Image size 2212x1659.
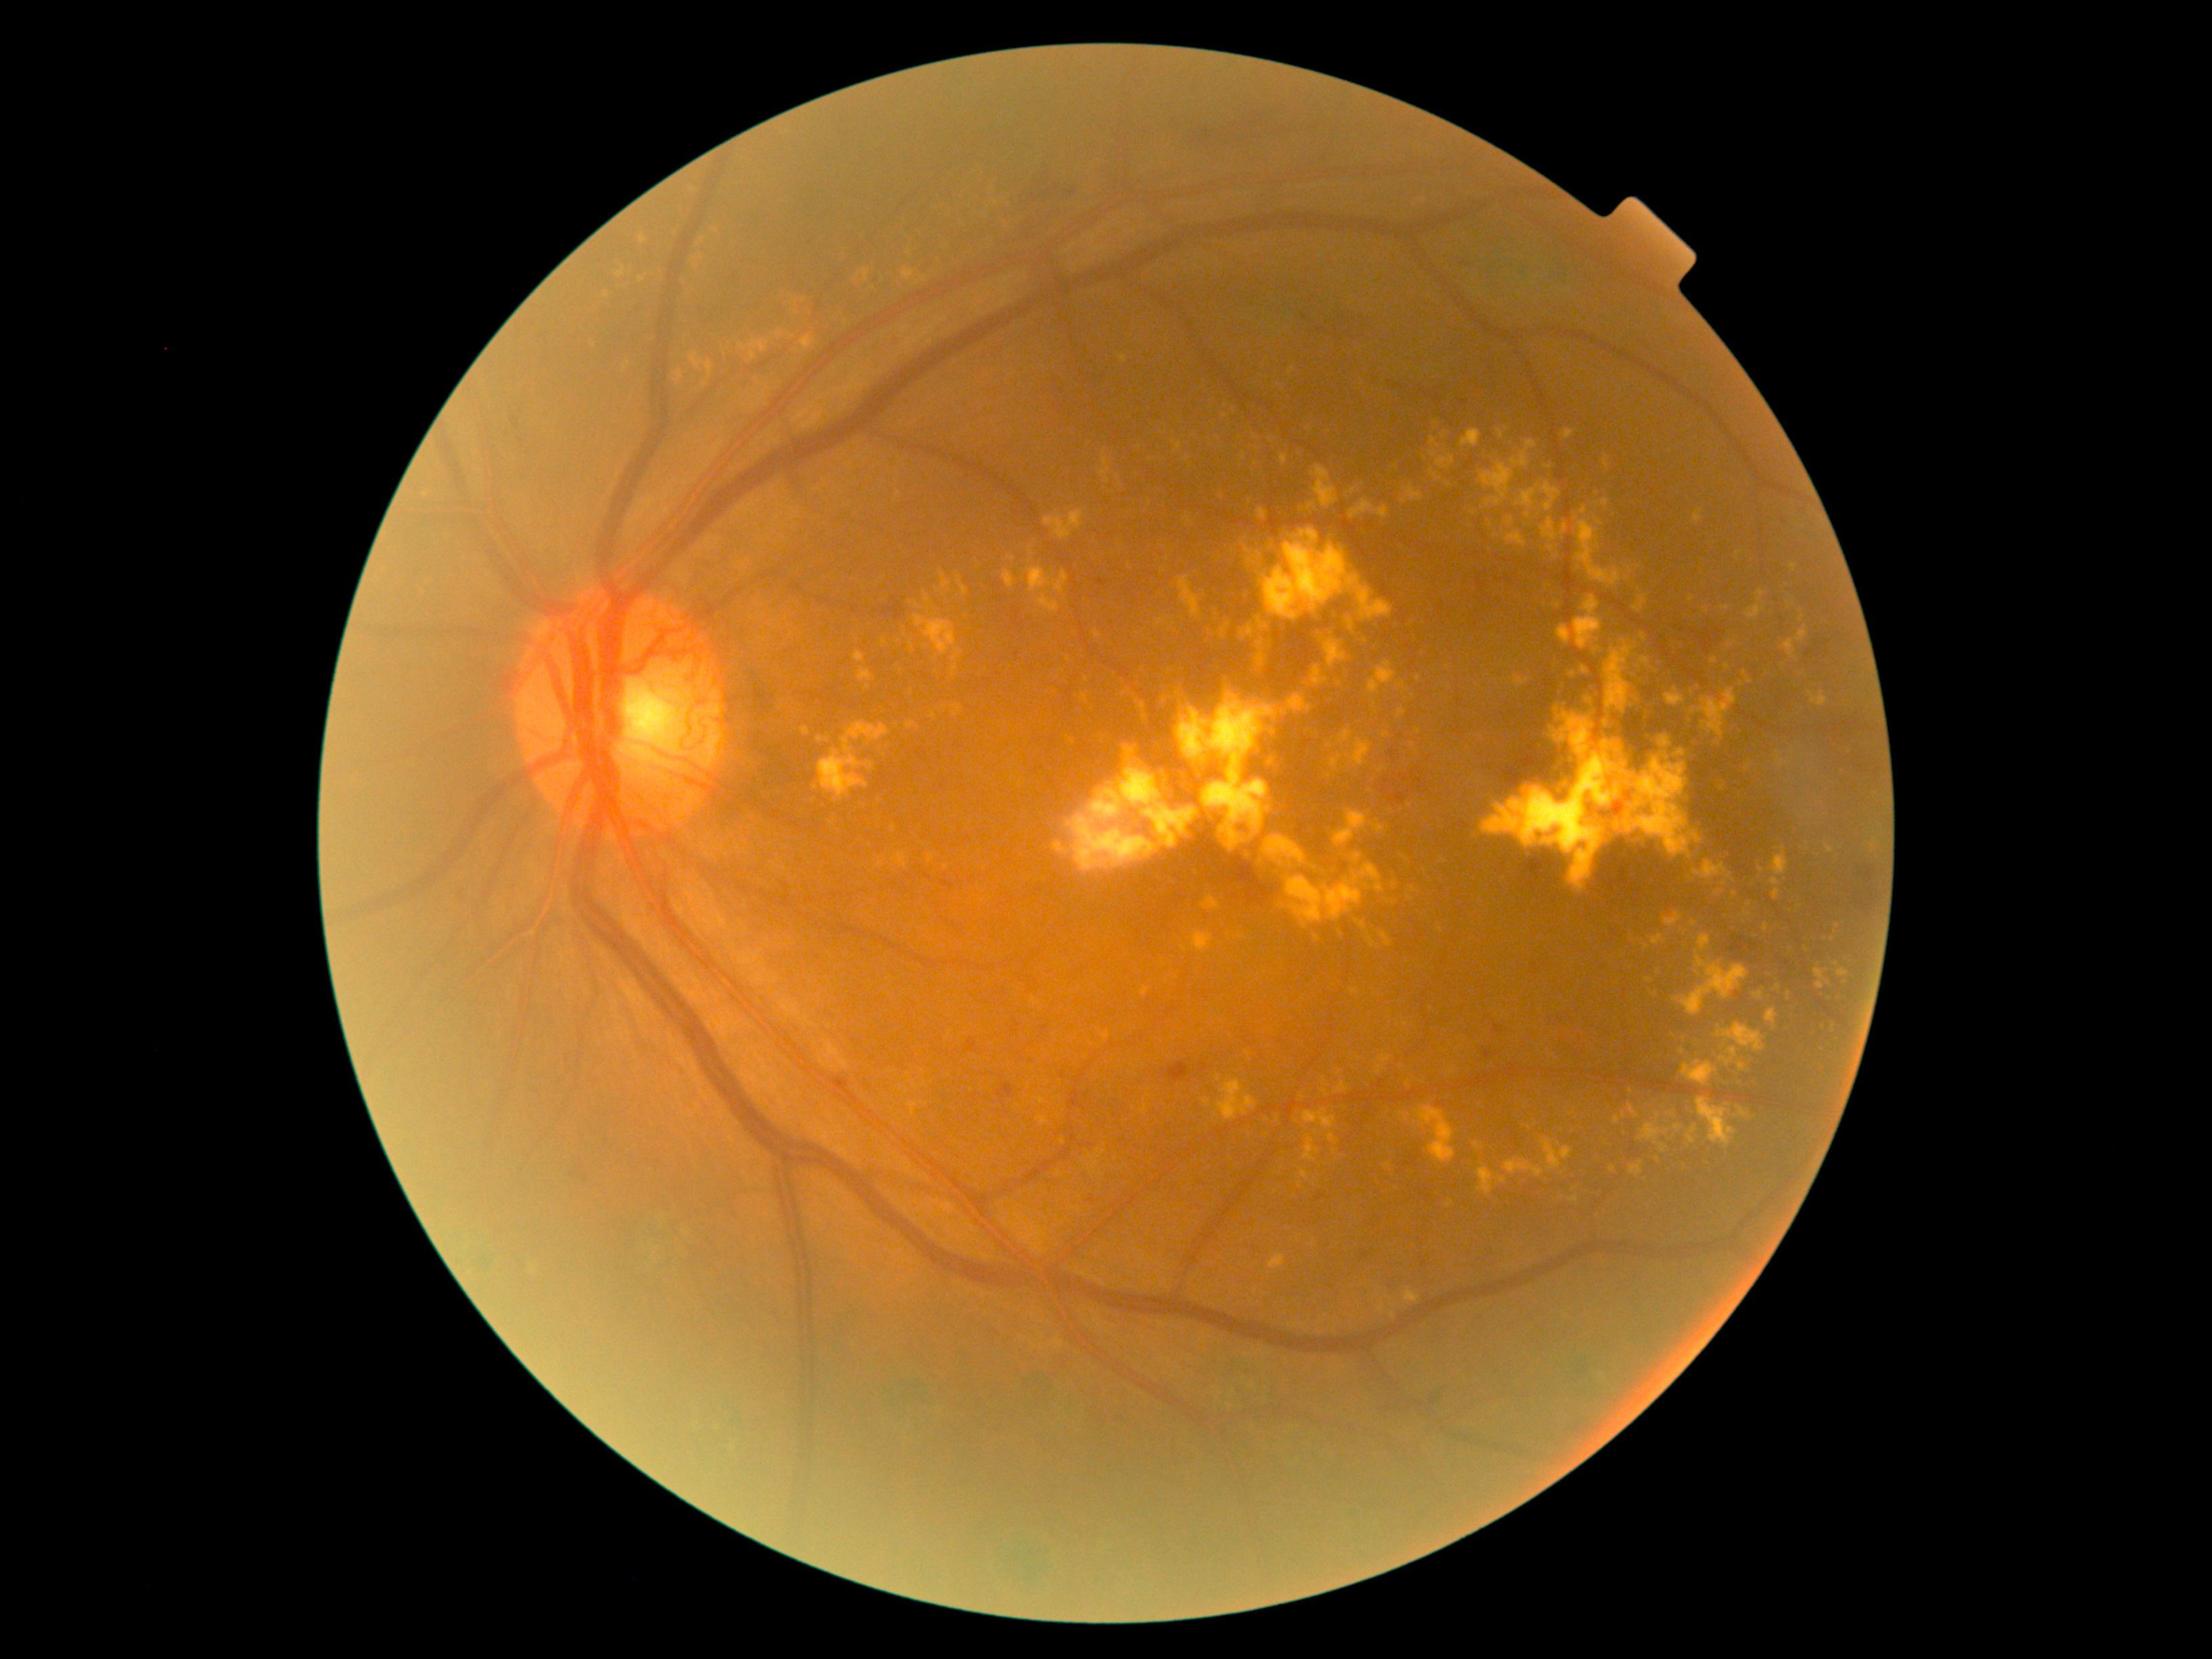

Retinopathy grade is 4 (PDR). Hard exudates include 1837, 970, 1849, 990; 1694, 860, 1732, 882; 958, 579, 968, 597; 1629, 1104, 1639, 1118; 1380, 1305, 1385, 1314; 1561, 756, 1568, 765; 906, 722, 917, 730; 1835, 997, 1843, 1004; 1679, 932, 1689, 939; 1161, 697, 1169, 703; 750, 340, 769, 361; 1550, 708, 1595, 758; 1382, 899, 1394, 909. Additional small hard exudates near [1658,1116]; [1383,1300]; [1551,549]; [1419,678]; [641,280]; [1218,1078]; [1744,673].